Image size 2346x1568. Color fundus image
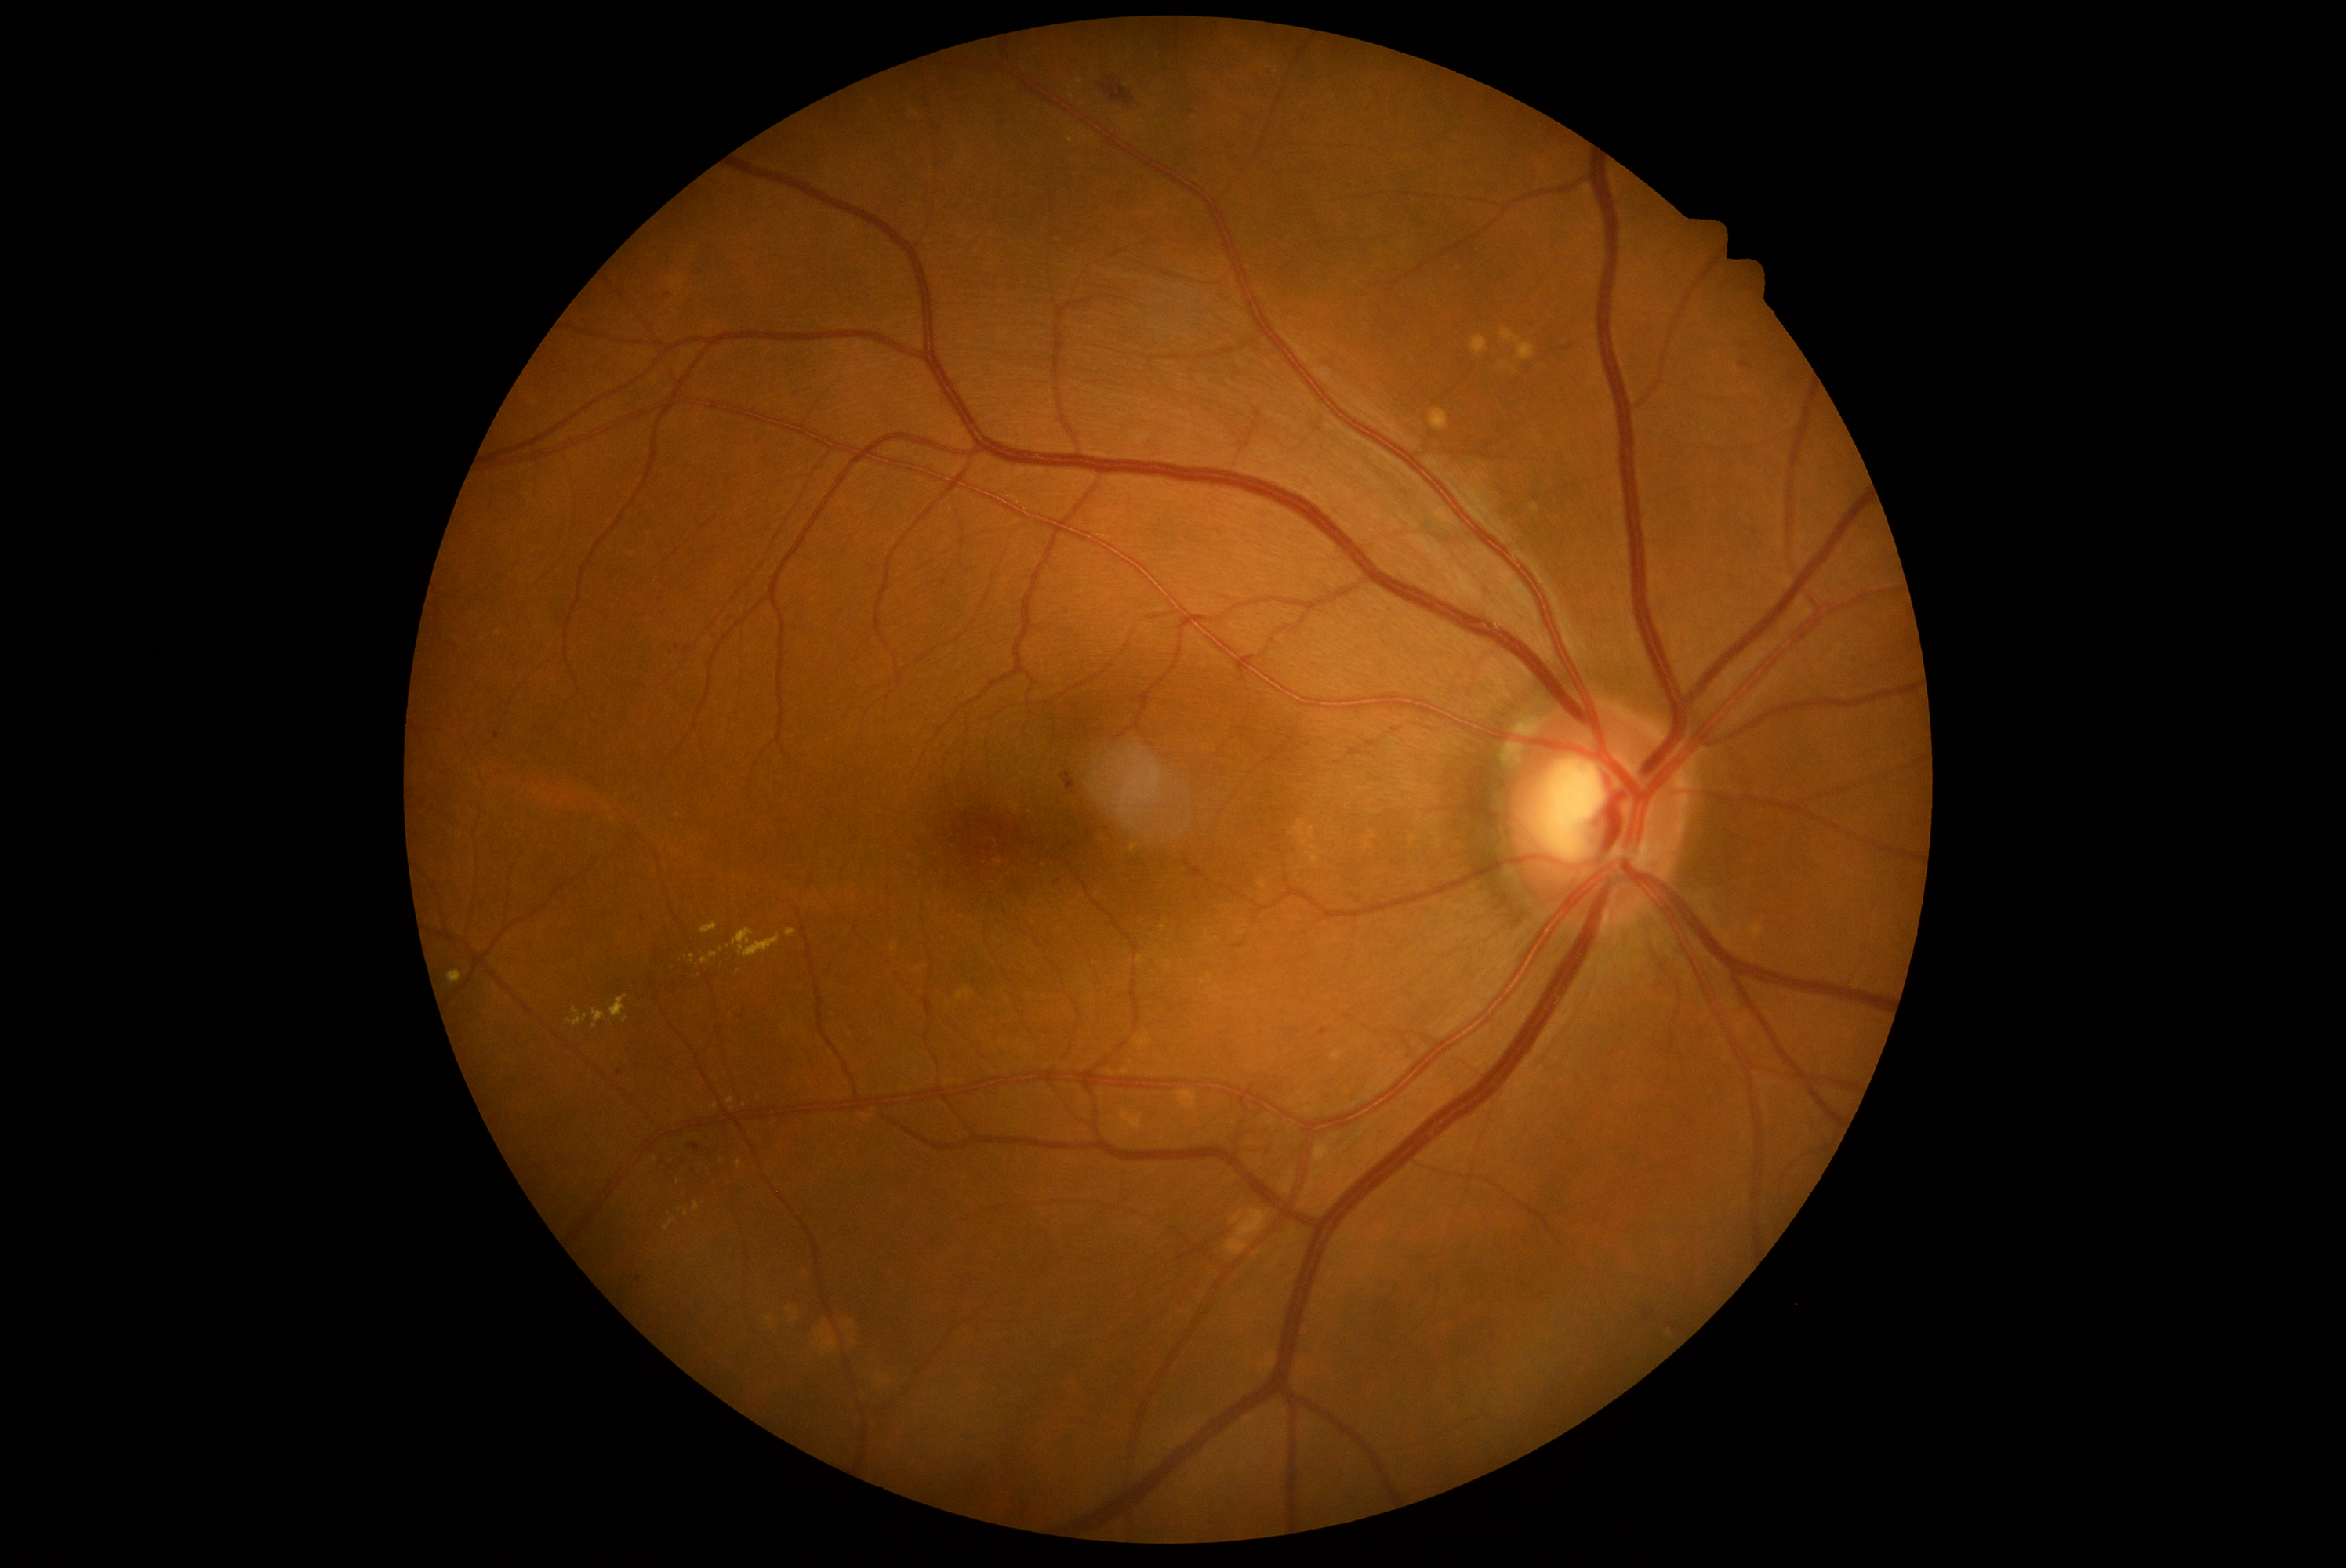 {"partial": true, "dr_grade": 2, "lesions": {"se": null, "ma": [[493, 731, 499, 739], [727, 615, 736, 620], [694, 1142, 700, 1150], [1320, 1029, 1329, 1036]], "ma_small": [[676, 648], [639, 1280], [658, 600], [619, 1073], [668, 295], [642, 918], [1058, 882], [1106, 829]], "ex": [[727, 1098, 735, 1106], [786, 929, 796, 938], [592, 1009, 606, 1028], [733, 929, 780, 959], [448, 971, 462, 985], [738, 1161, 743, 1169], [702, 953, 717, 965]], "ex_small": [[716, 1107], [1071, 140], [626, 1020], [678, 1183], [721, 950], [1071, 96]], "he": [[1102, 84, 1136, 106], [1643, 1310, 1652, 1321], [1061, 772, 1075, 791], [1740, 361, 1752, 369]], "he_small": [[1111, 79]]}}